1932 by 1916 pixels: 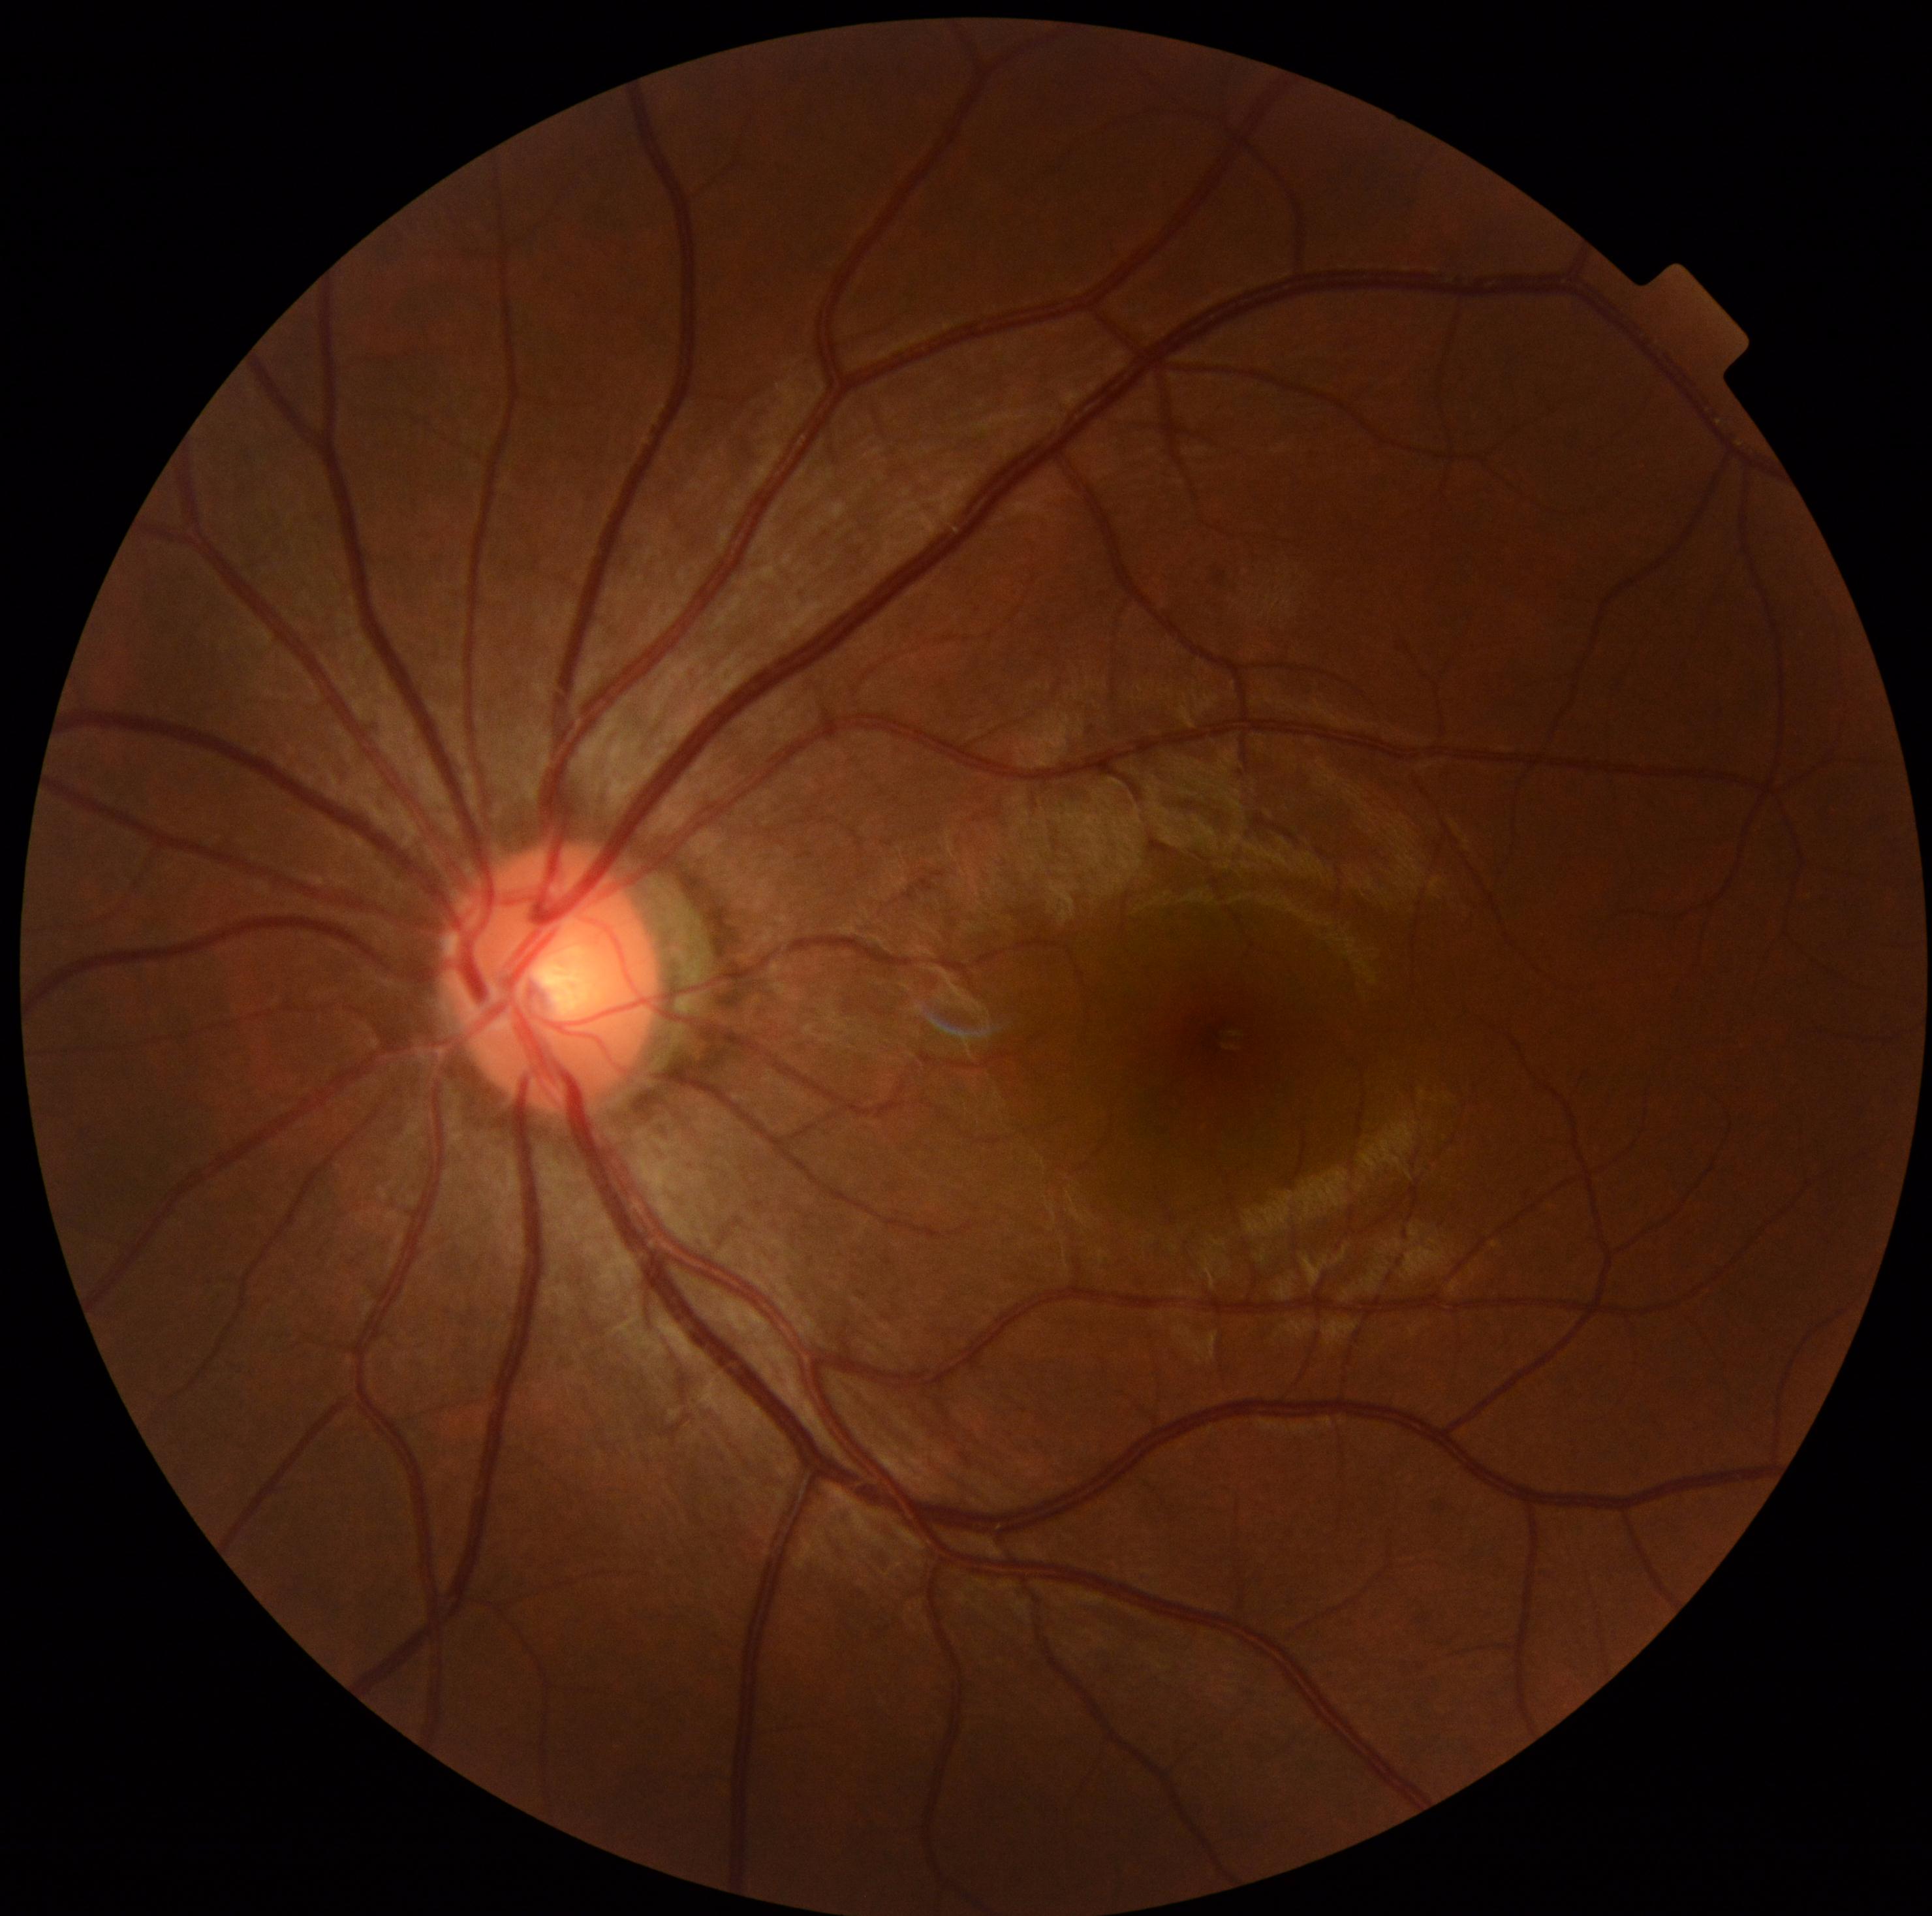 DR severity: 0.